Image size 1440x1080; infant wide-field fundus photograph.
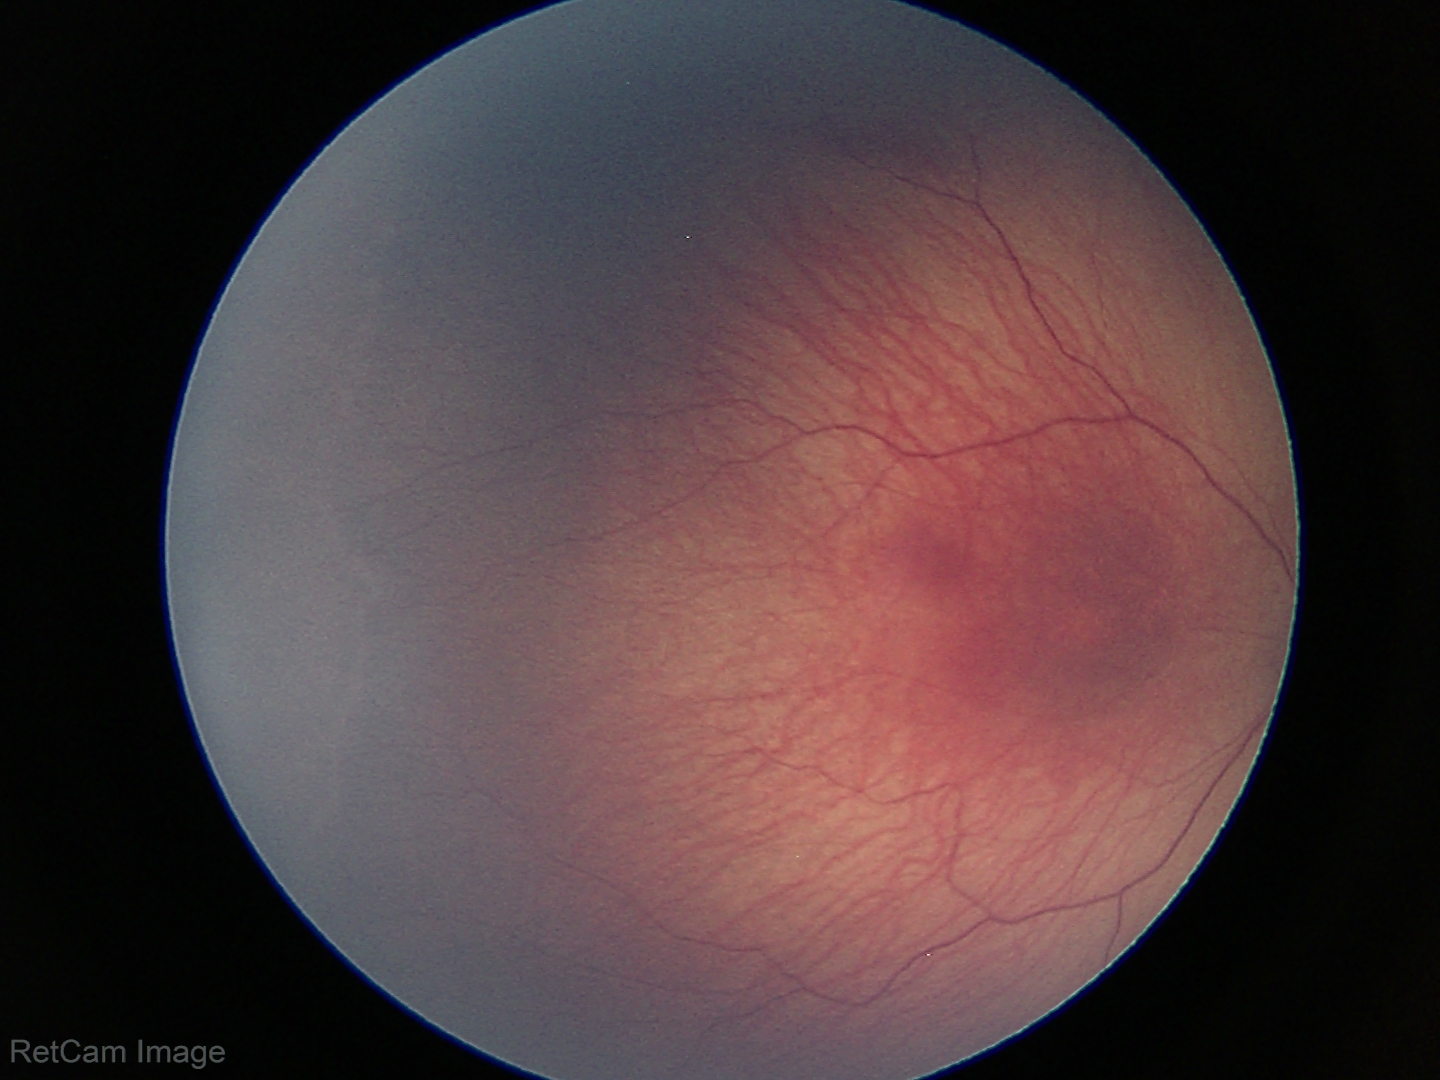

Examination diagnosed as retinopathy of prematurity (ROP) stage 1 — demarcation line between vascular and avascular retina.
Without plus disease.